848x848px · diabetic retinopathy graded by the modified Davis classification.
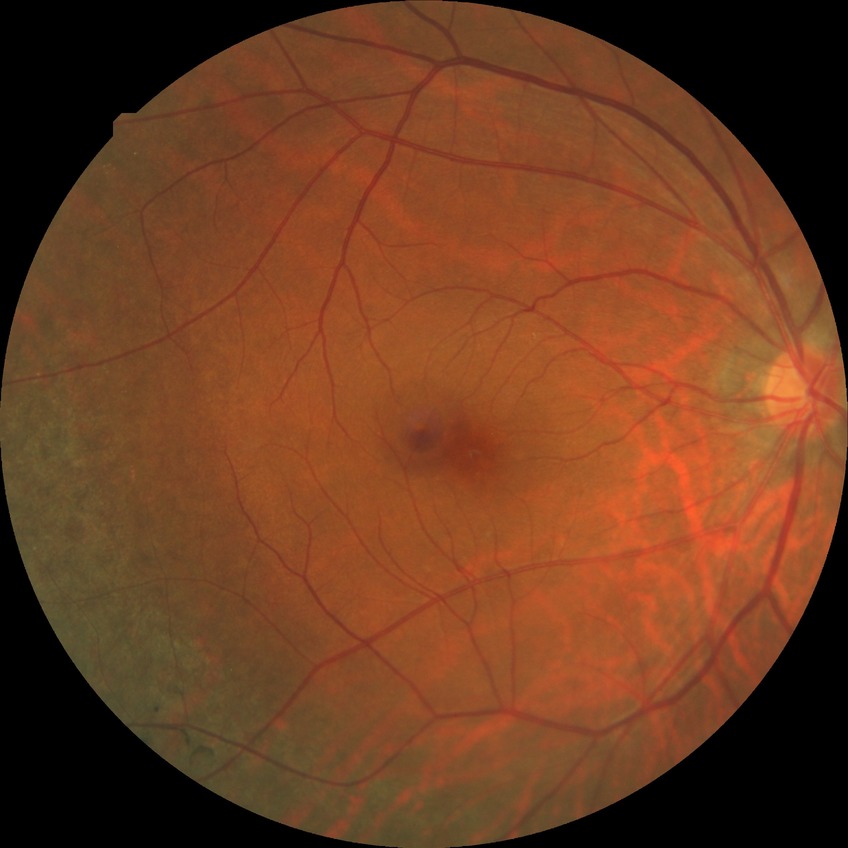
modified Davis classification: no diabetic retinopathy.